2352 by 1568 pixels: 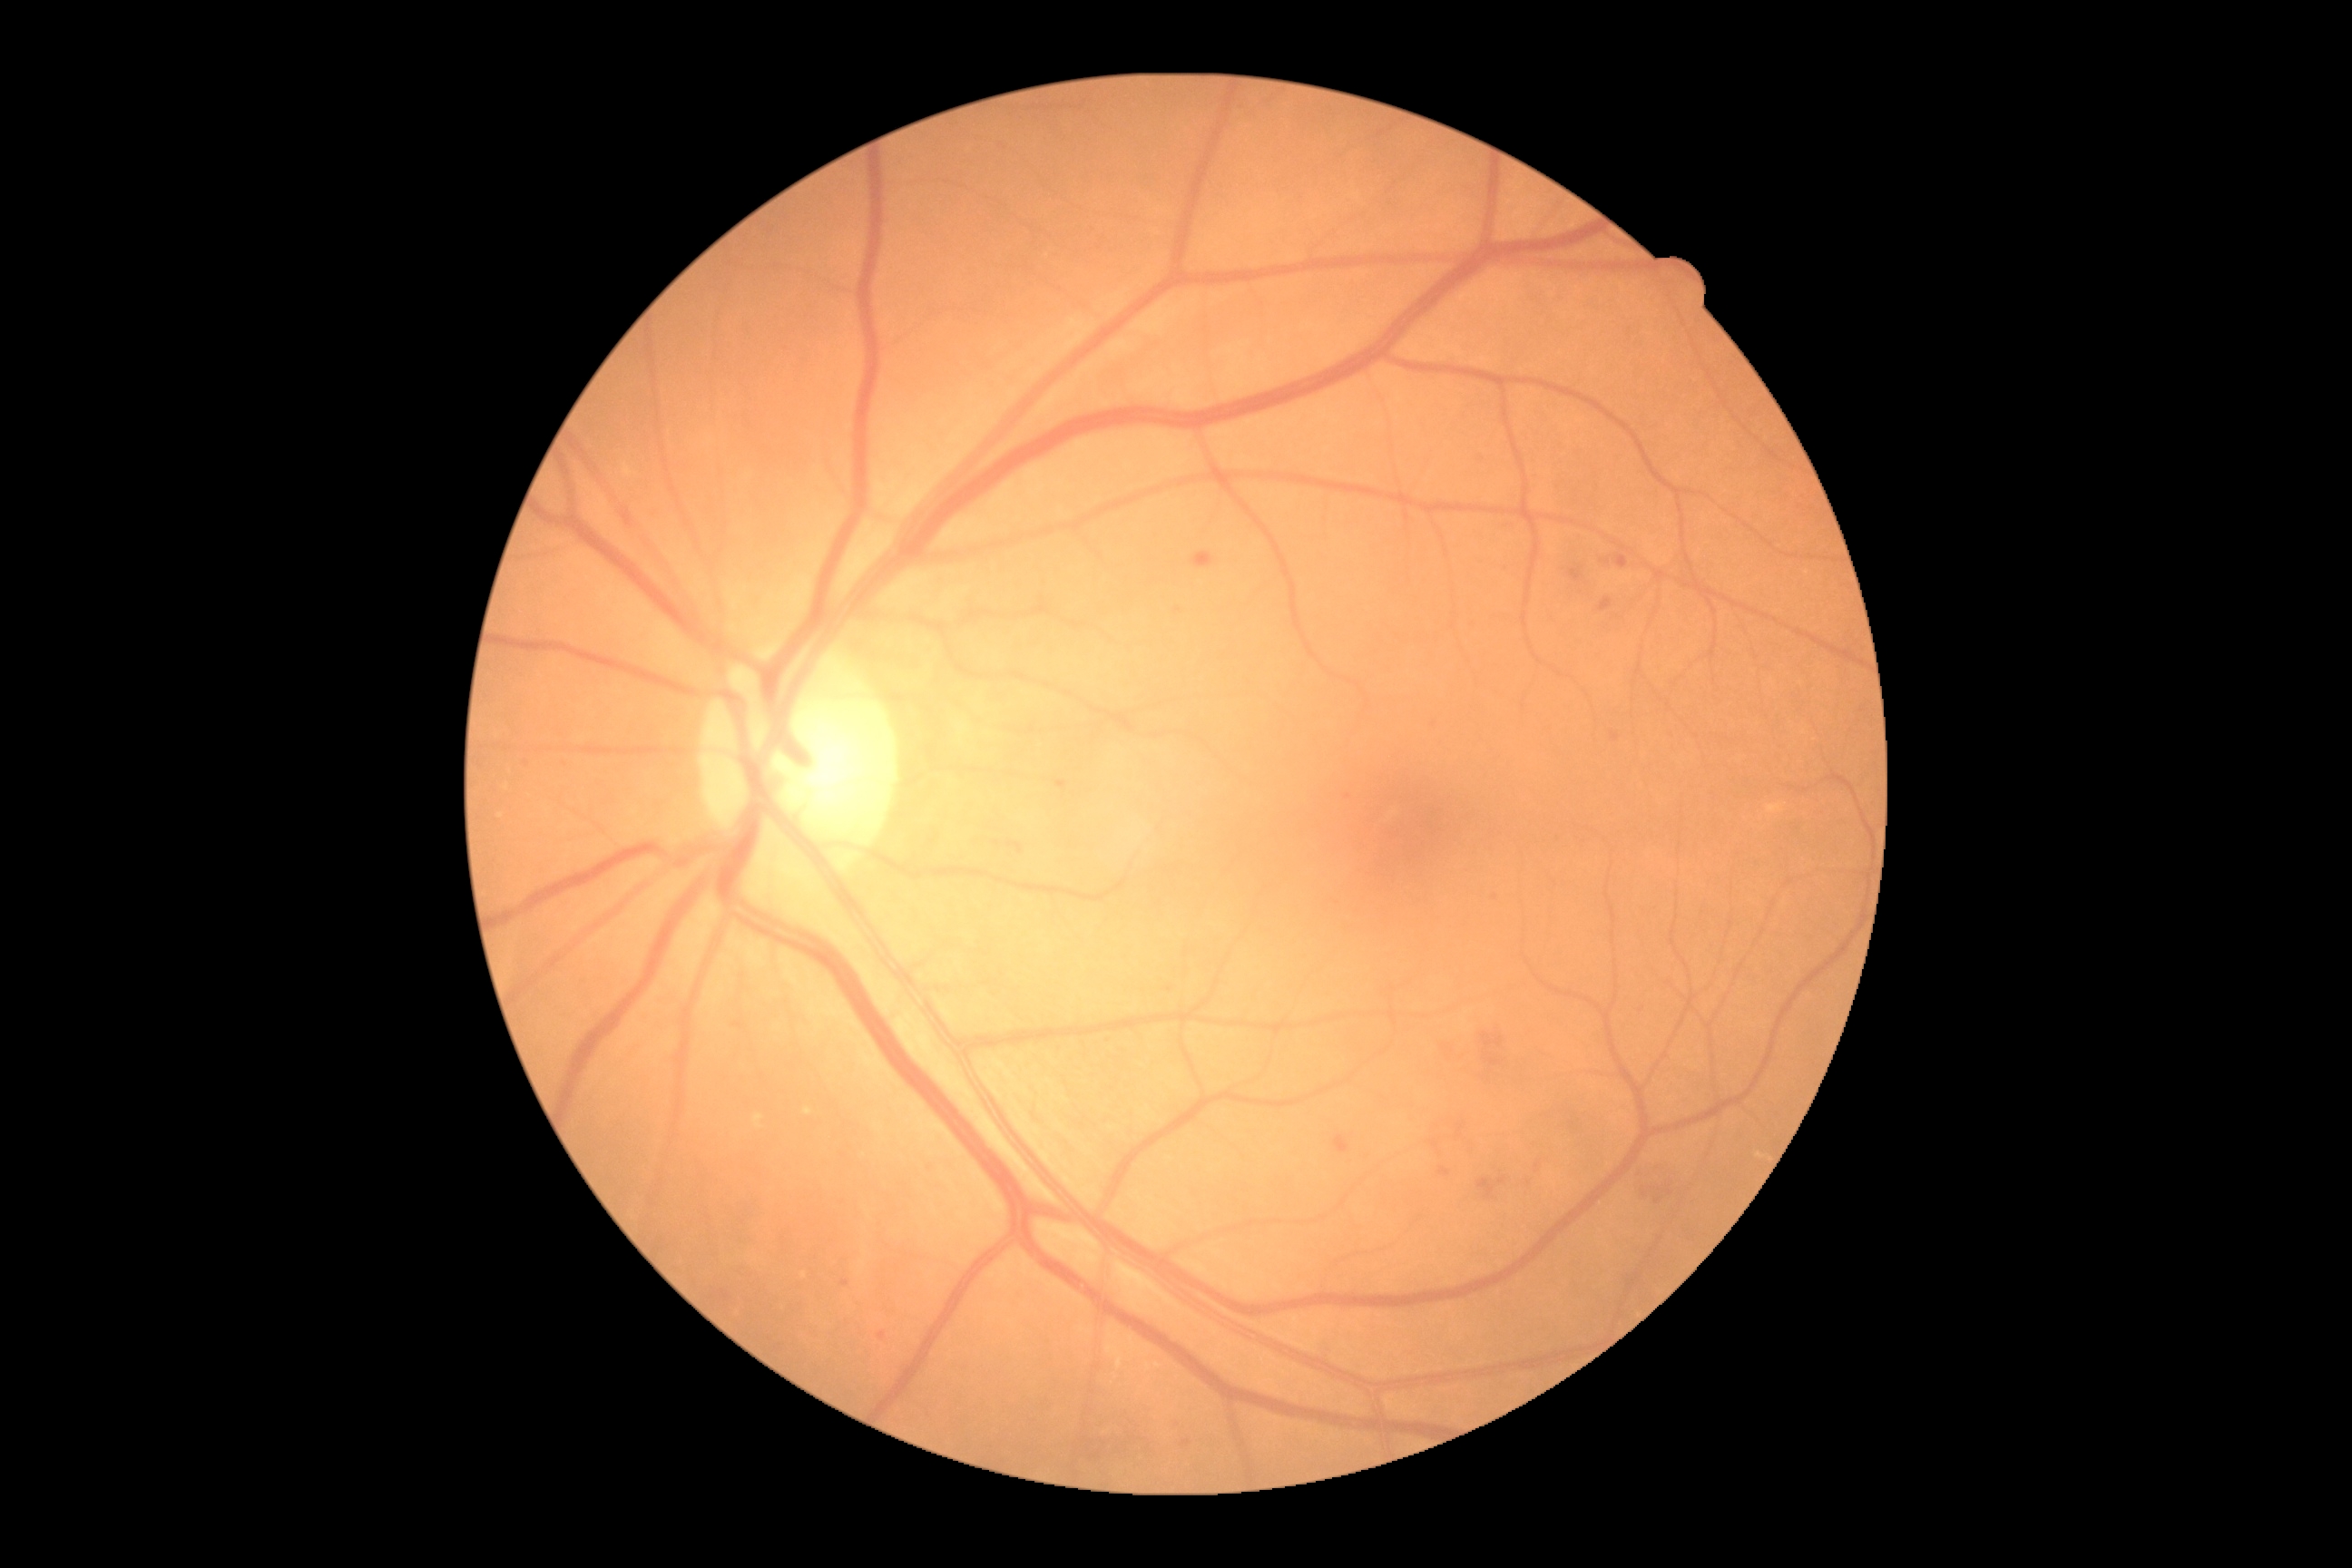 Diabetic retinopathy (DR): moderate NPDR (grade 2)
soft exudates (SEs): not present
hard exudates (EXs): Rect(754, 1115, 765, 1130); Rect(803, 1108, 814, 1115)
Additional small EXs near [501,816]; [805,1276]; [507,788]
hemorrhages (HEs): Rect(1438, 1168, 1451, 1177); Rect(1616, 554, 1629, 569); Rect(1522, 1181, 1534, 1190); Rect(1478, 1177, 1507, 1200); Rect(1191, 551, 1215, 569); Rect(1482, 1034, 1504, 1050); Rect(1529, 1162, 1542, 1173); Rect(1335, 1135, 1349, 1153); Rect(1600, 598, 1612, 612); Rect(1645, 1173, 1678, 1204); Rect(1603, 560, 1611, 565); Rect(1440, 1043, 1449, 1055); Rect(1485, 1054, 1502, 1066); Rect(1456, 1124, 1464, 1135); Rect(1569, 567, 1583, 582)
Additional small HEs near [1434,1144]
microaneurysms (MAs): Rect(520, 760, 529, 765); Rect(1181, 1440, 1191, 1447); Rect(734, 1023, 743, 1028); Rect(841, 1280, 850, 1288); Rect(879, 1333, 887, 1340); Rect(1057, 781, 1068, 789); Rect(1611, 732, 1620, 741)
Additional small MAs near [1178,611]; [1434,725]; [1481,456]; [1348,796]; [1495,898]